Optic nerve head crop.
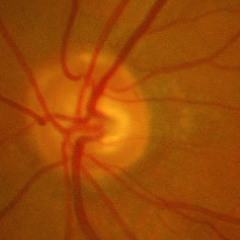

Glaucoma is present.
Advanced glaucomatous optic neuropathy.
Diagnostic criteria: near-total cupping of the optic nerve head, with or without severe visual field loss within the central 10 degrees of fixation.